CFP · IOP (non-contact tonometry): 13 mmHg · Topcon TRC-NW400 — 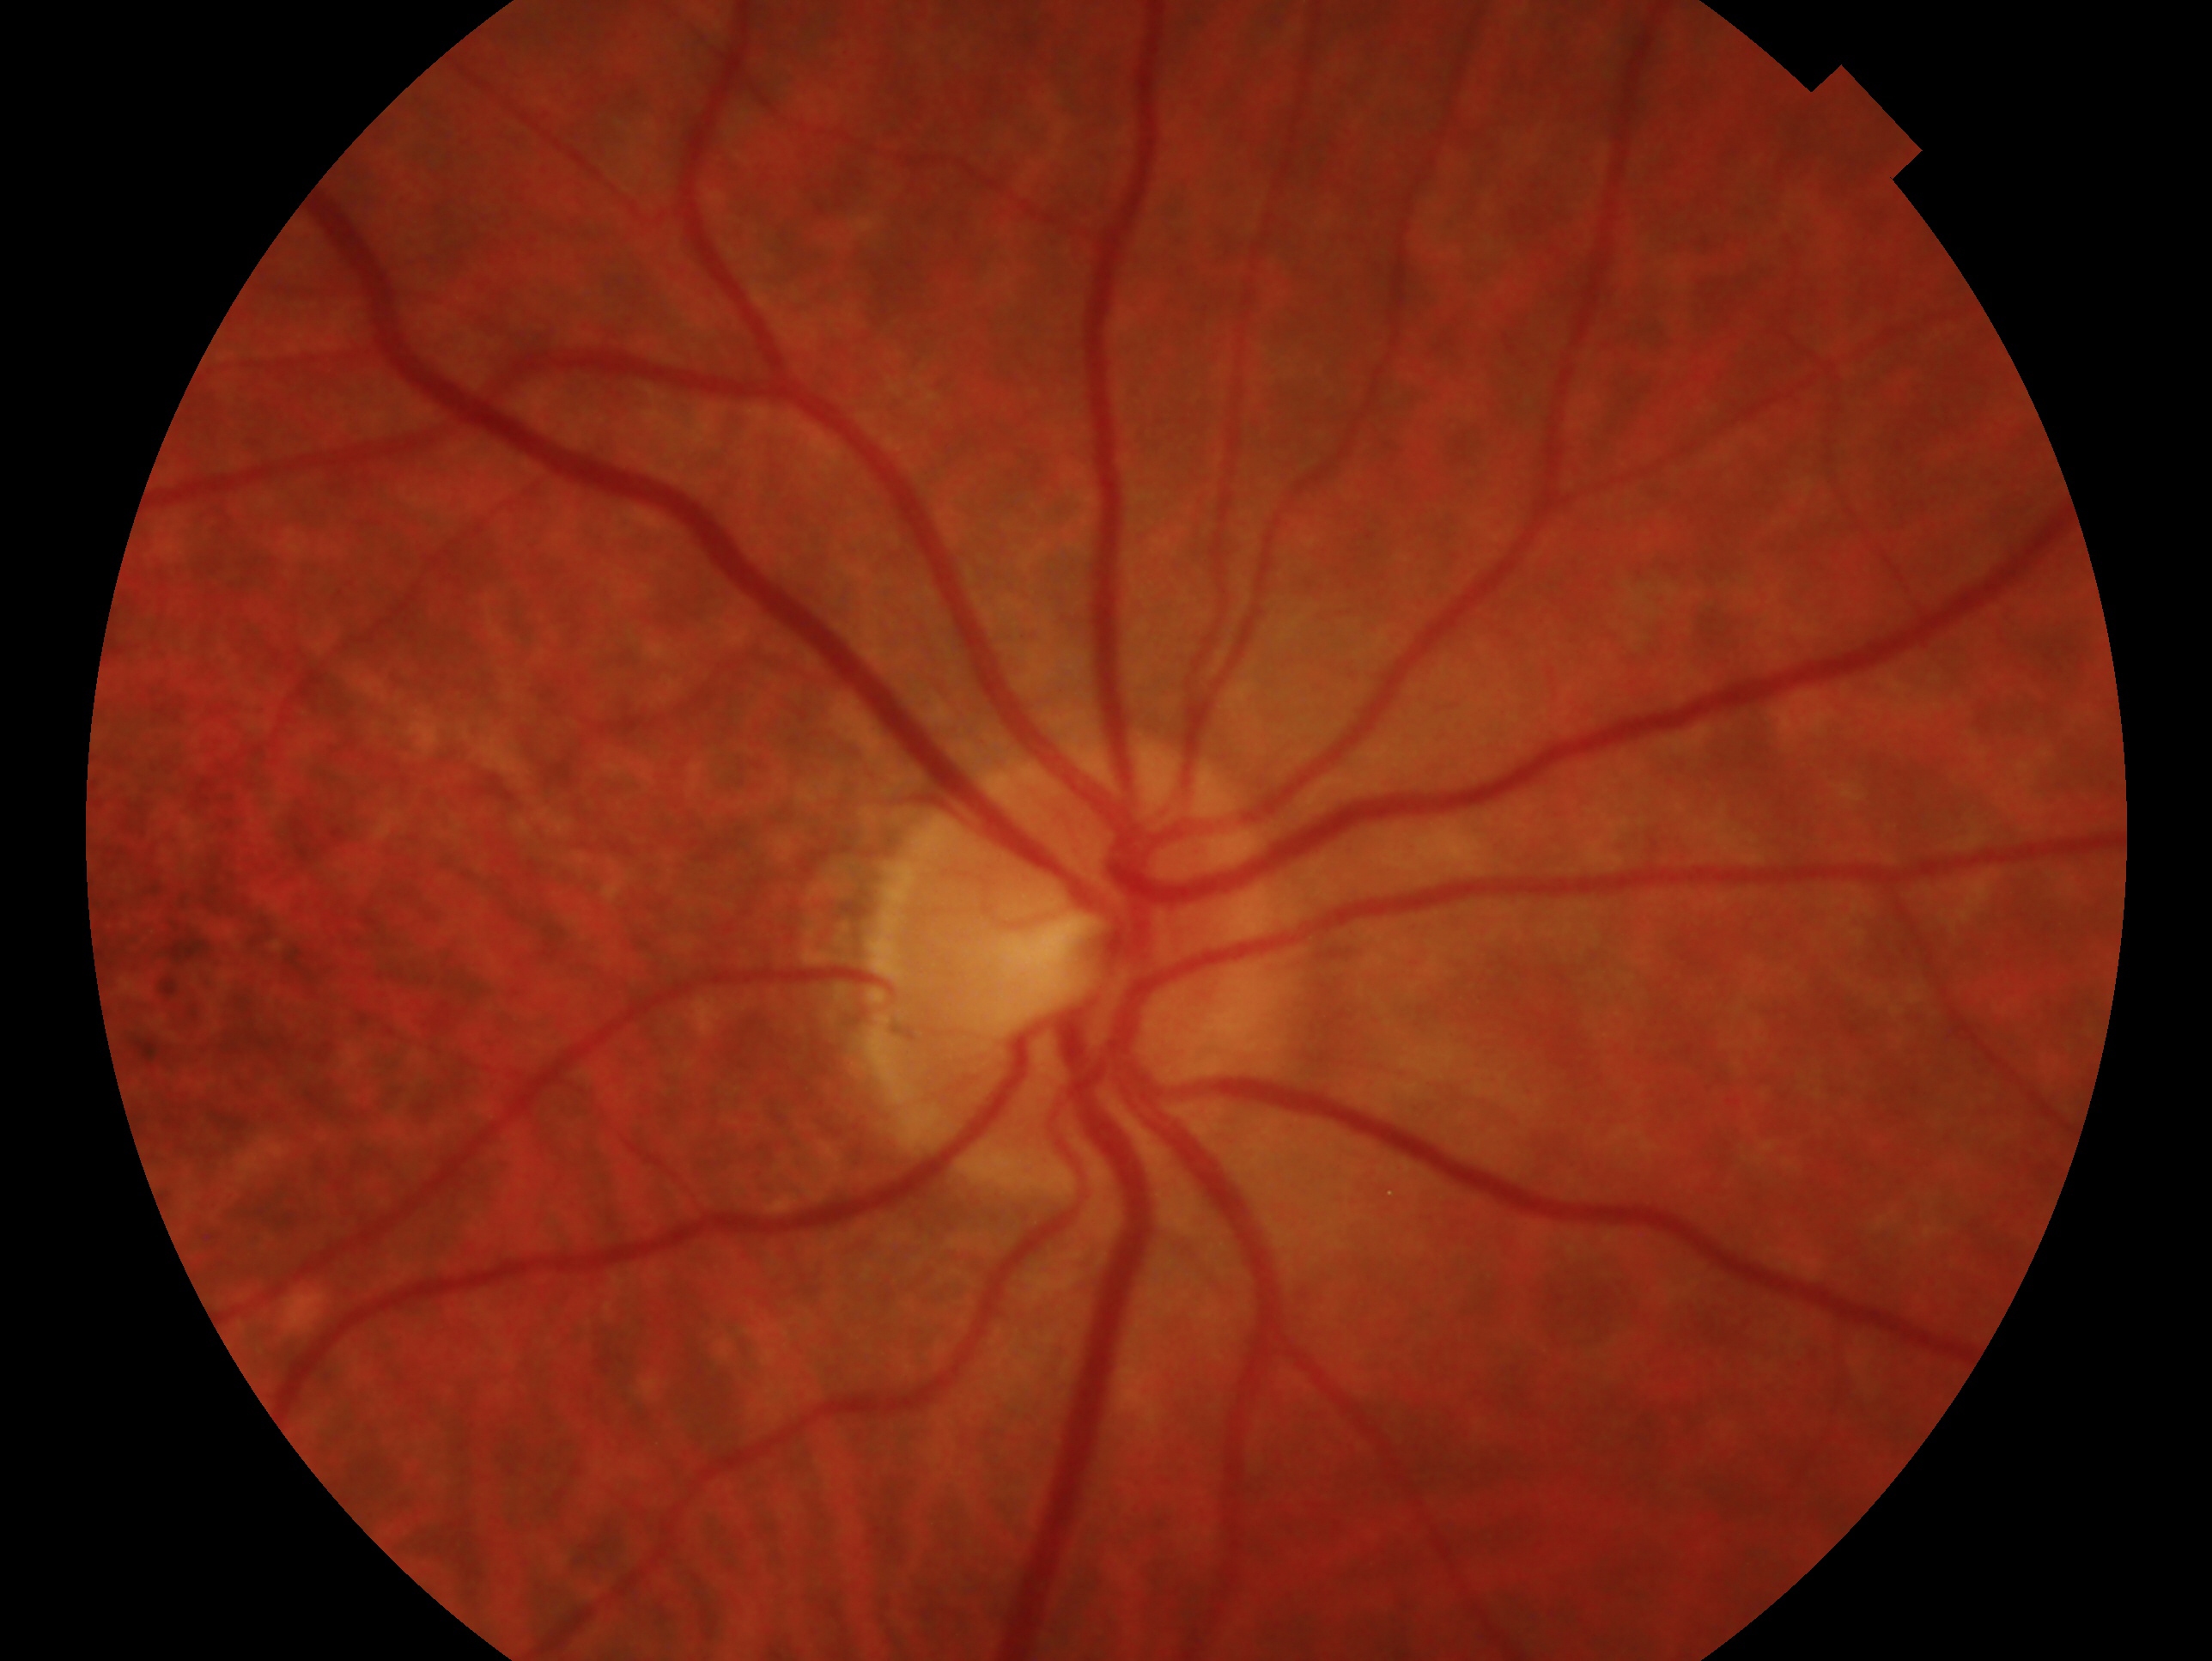 Diagnosis: negative for glaucoma.
This is the right eye.